2352x1568px, color fundus photograph: 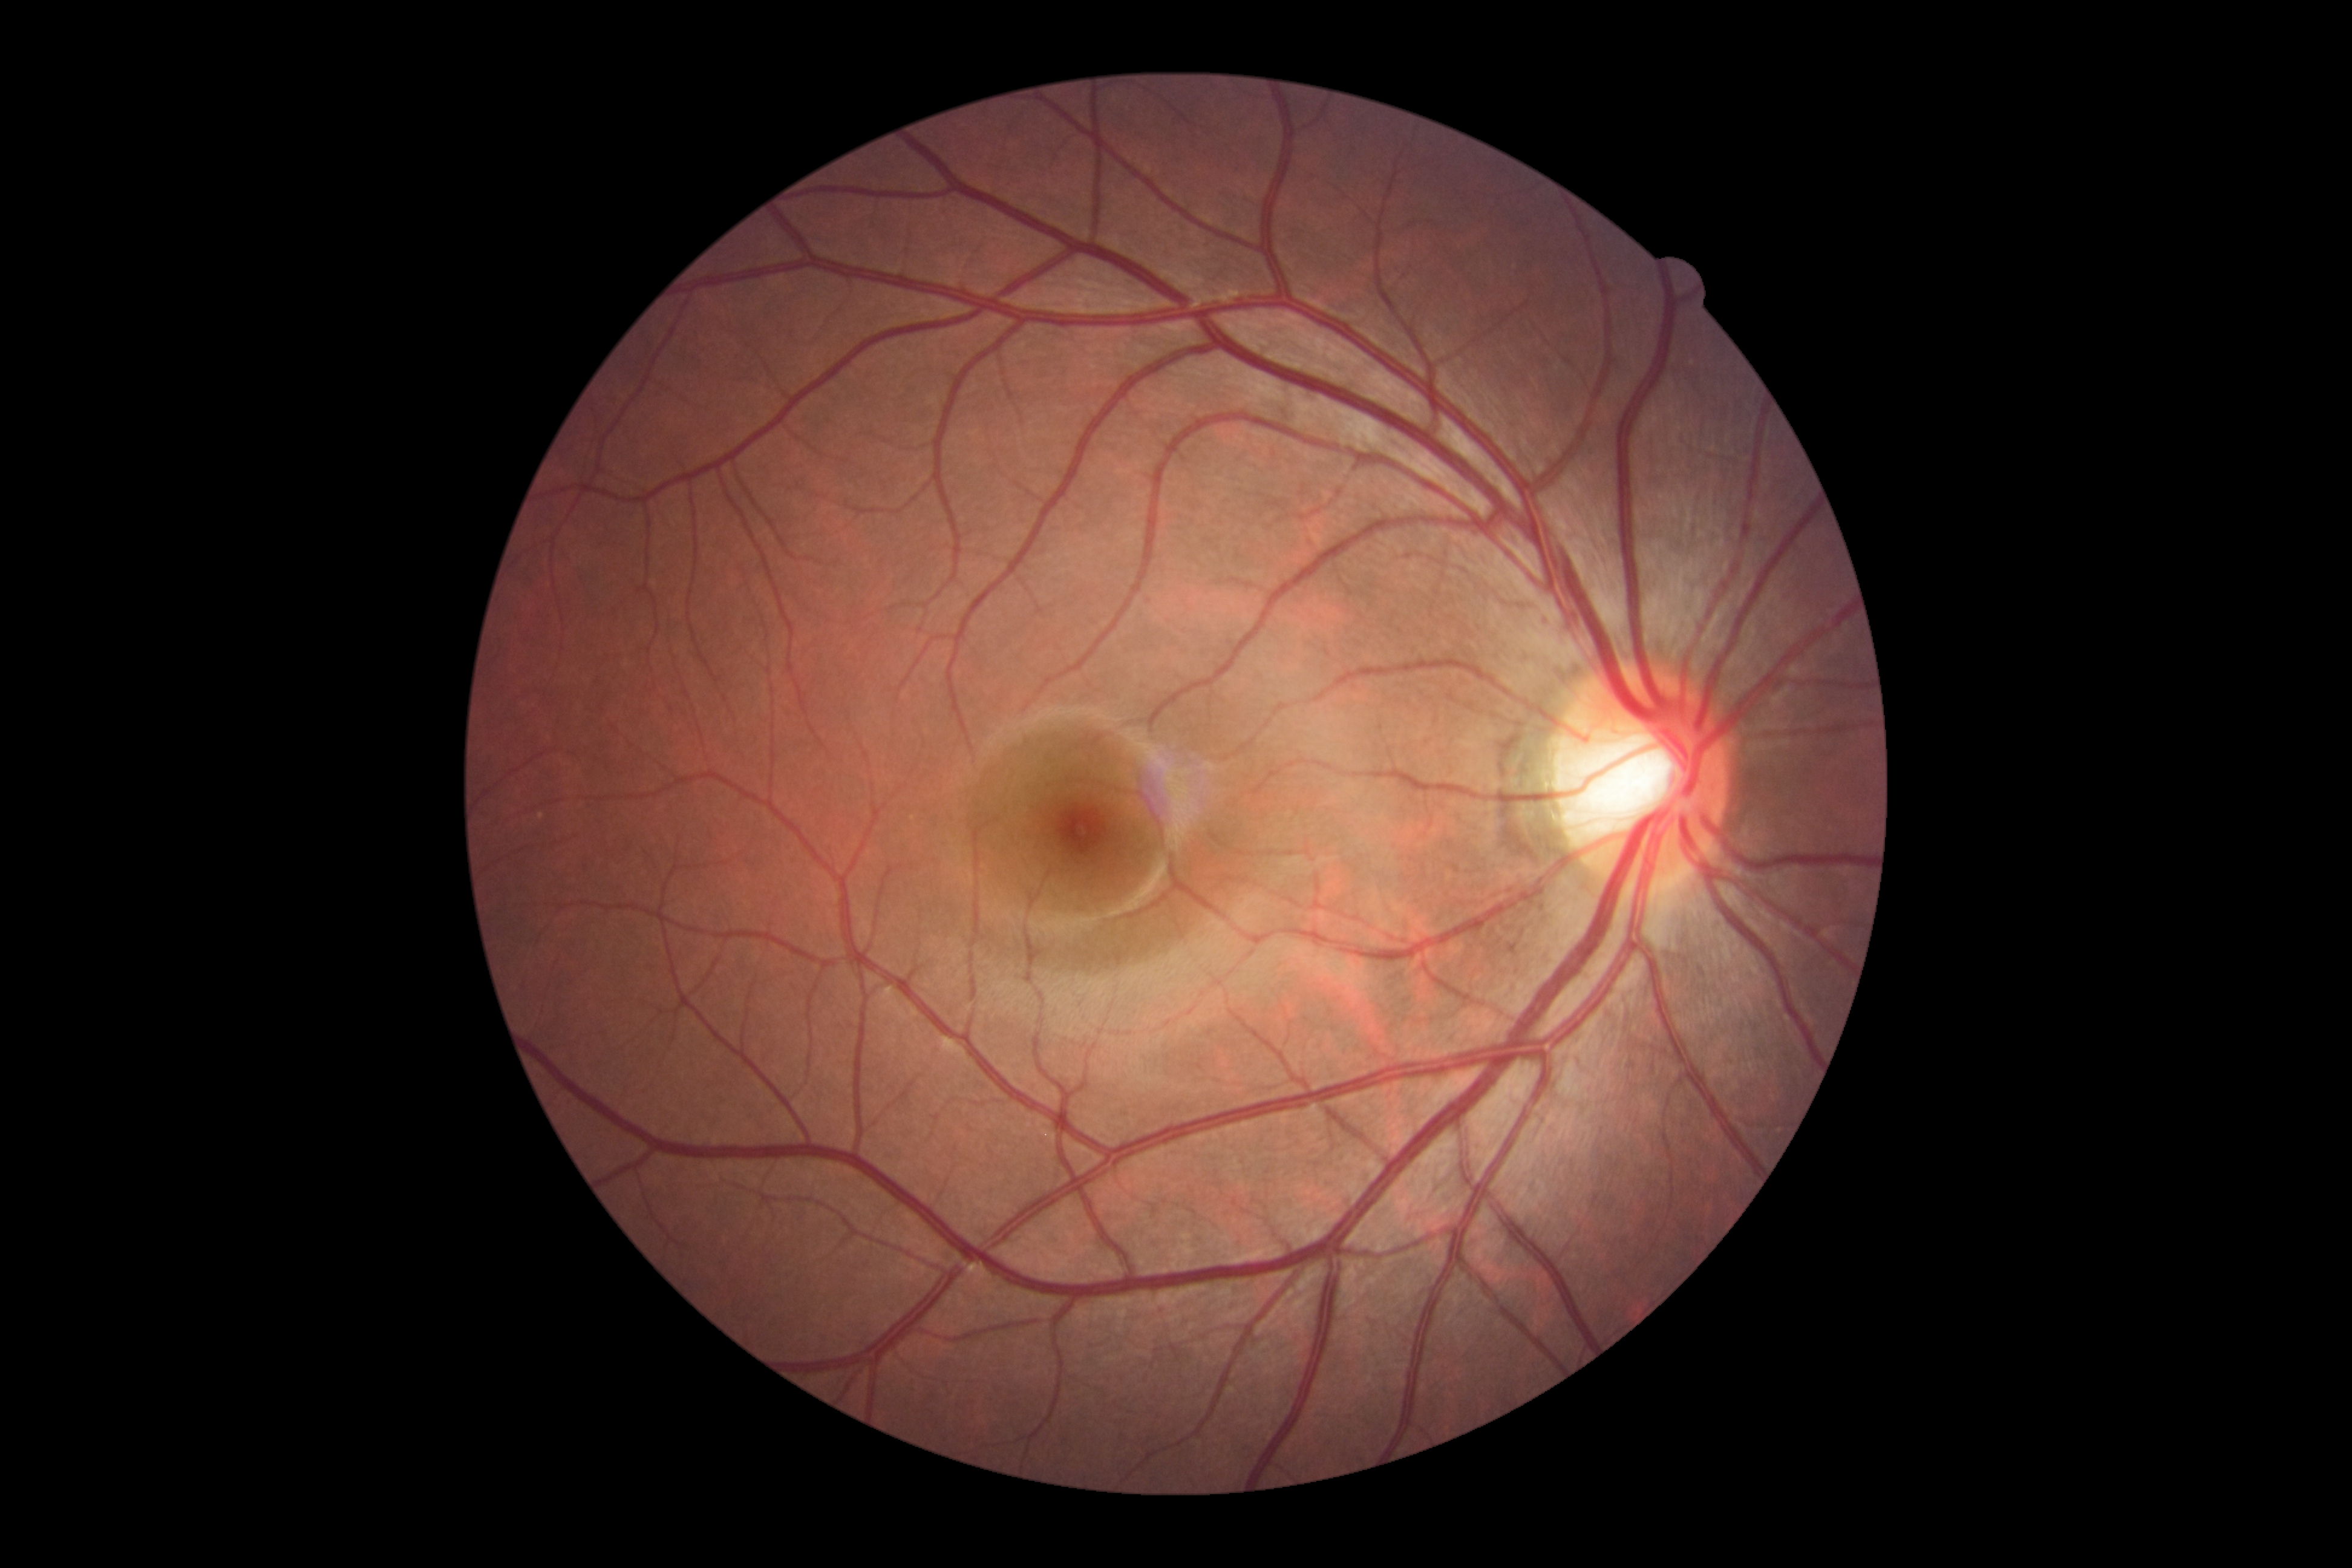
Annotations:
• diabetic retinopathy (DR) — no apparent retinopathy (grade 0)